FOV: 45 degrees.
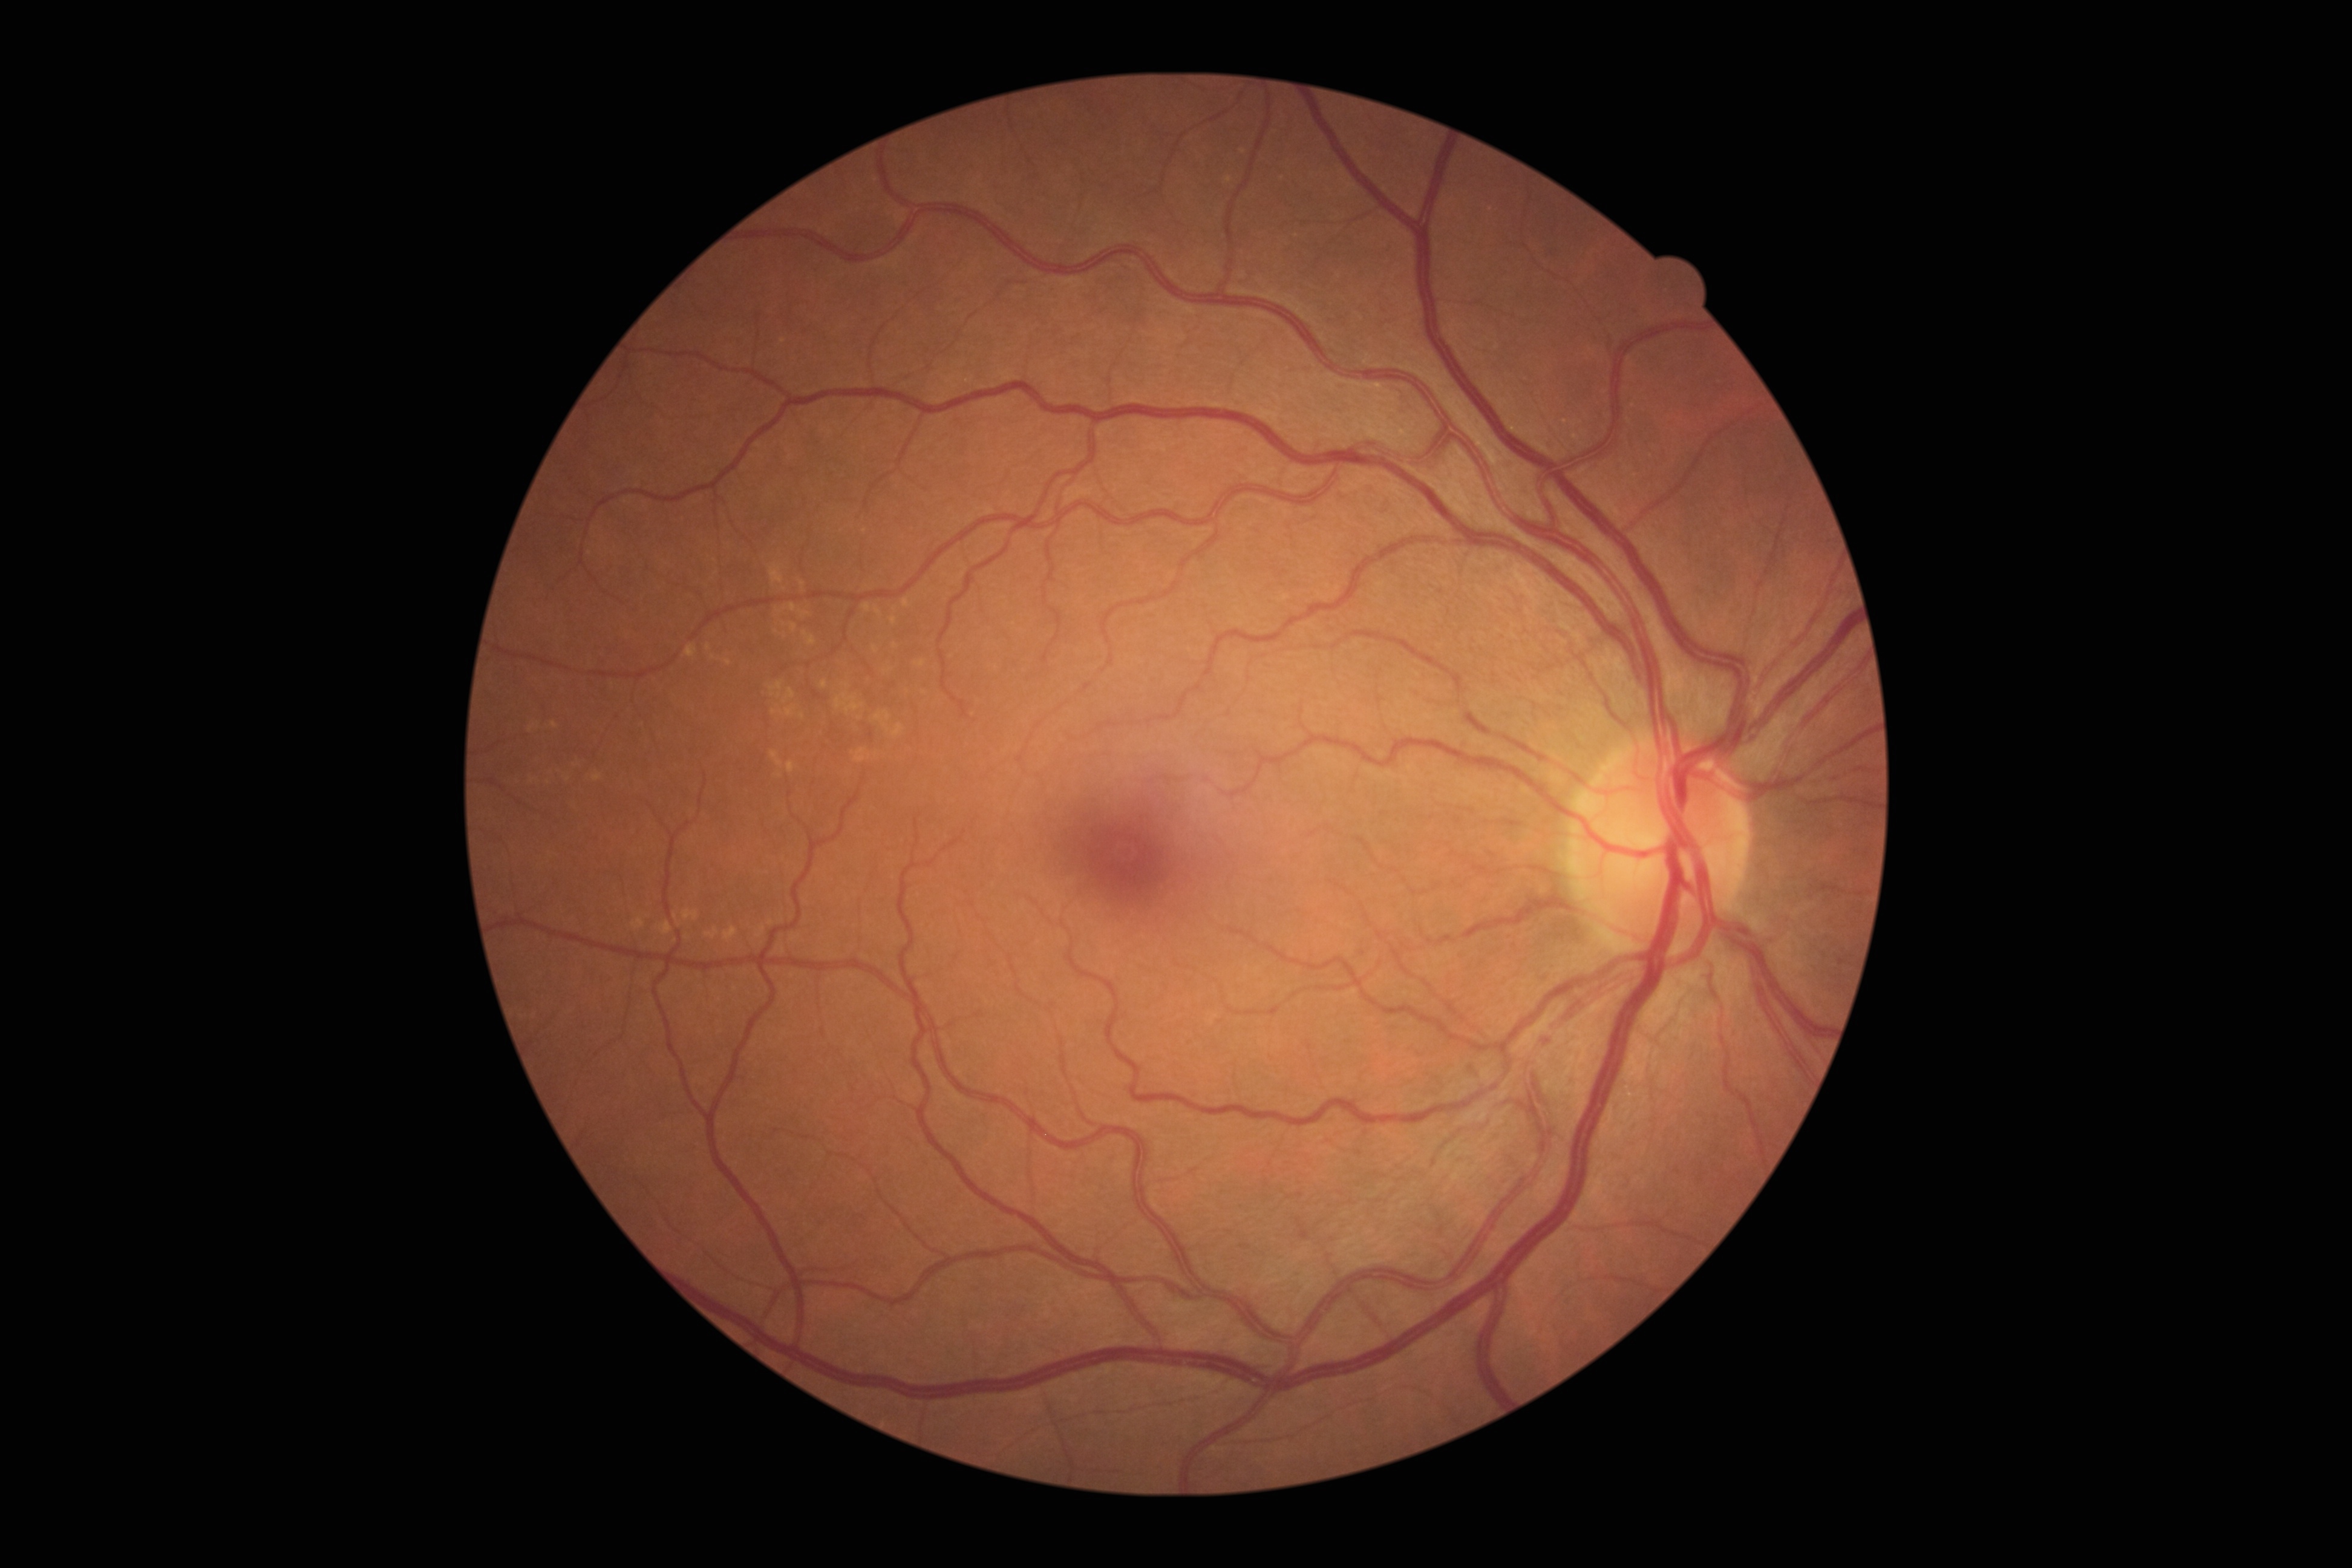

diabetic retinopathy (DR) = grade 0.